45° FOV.
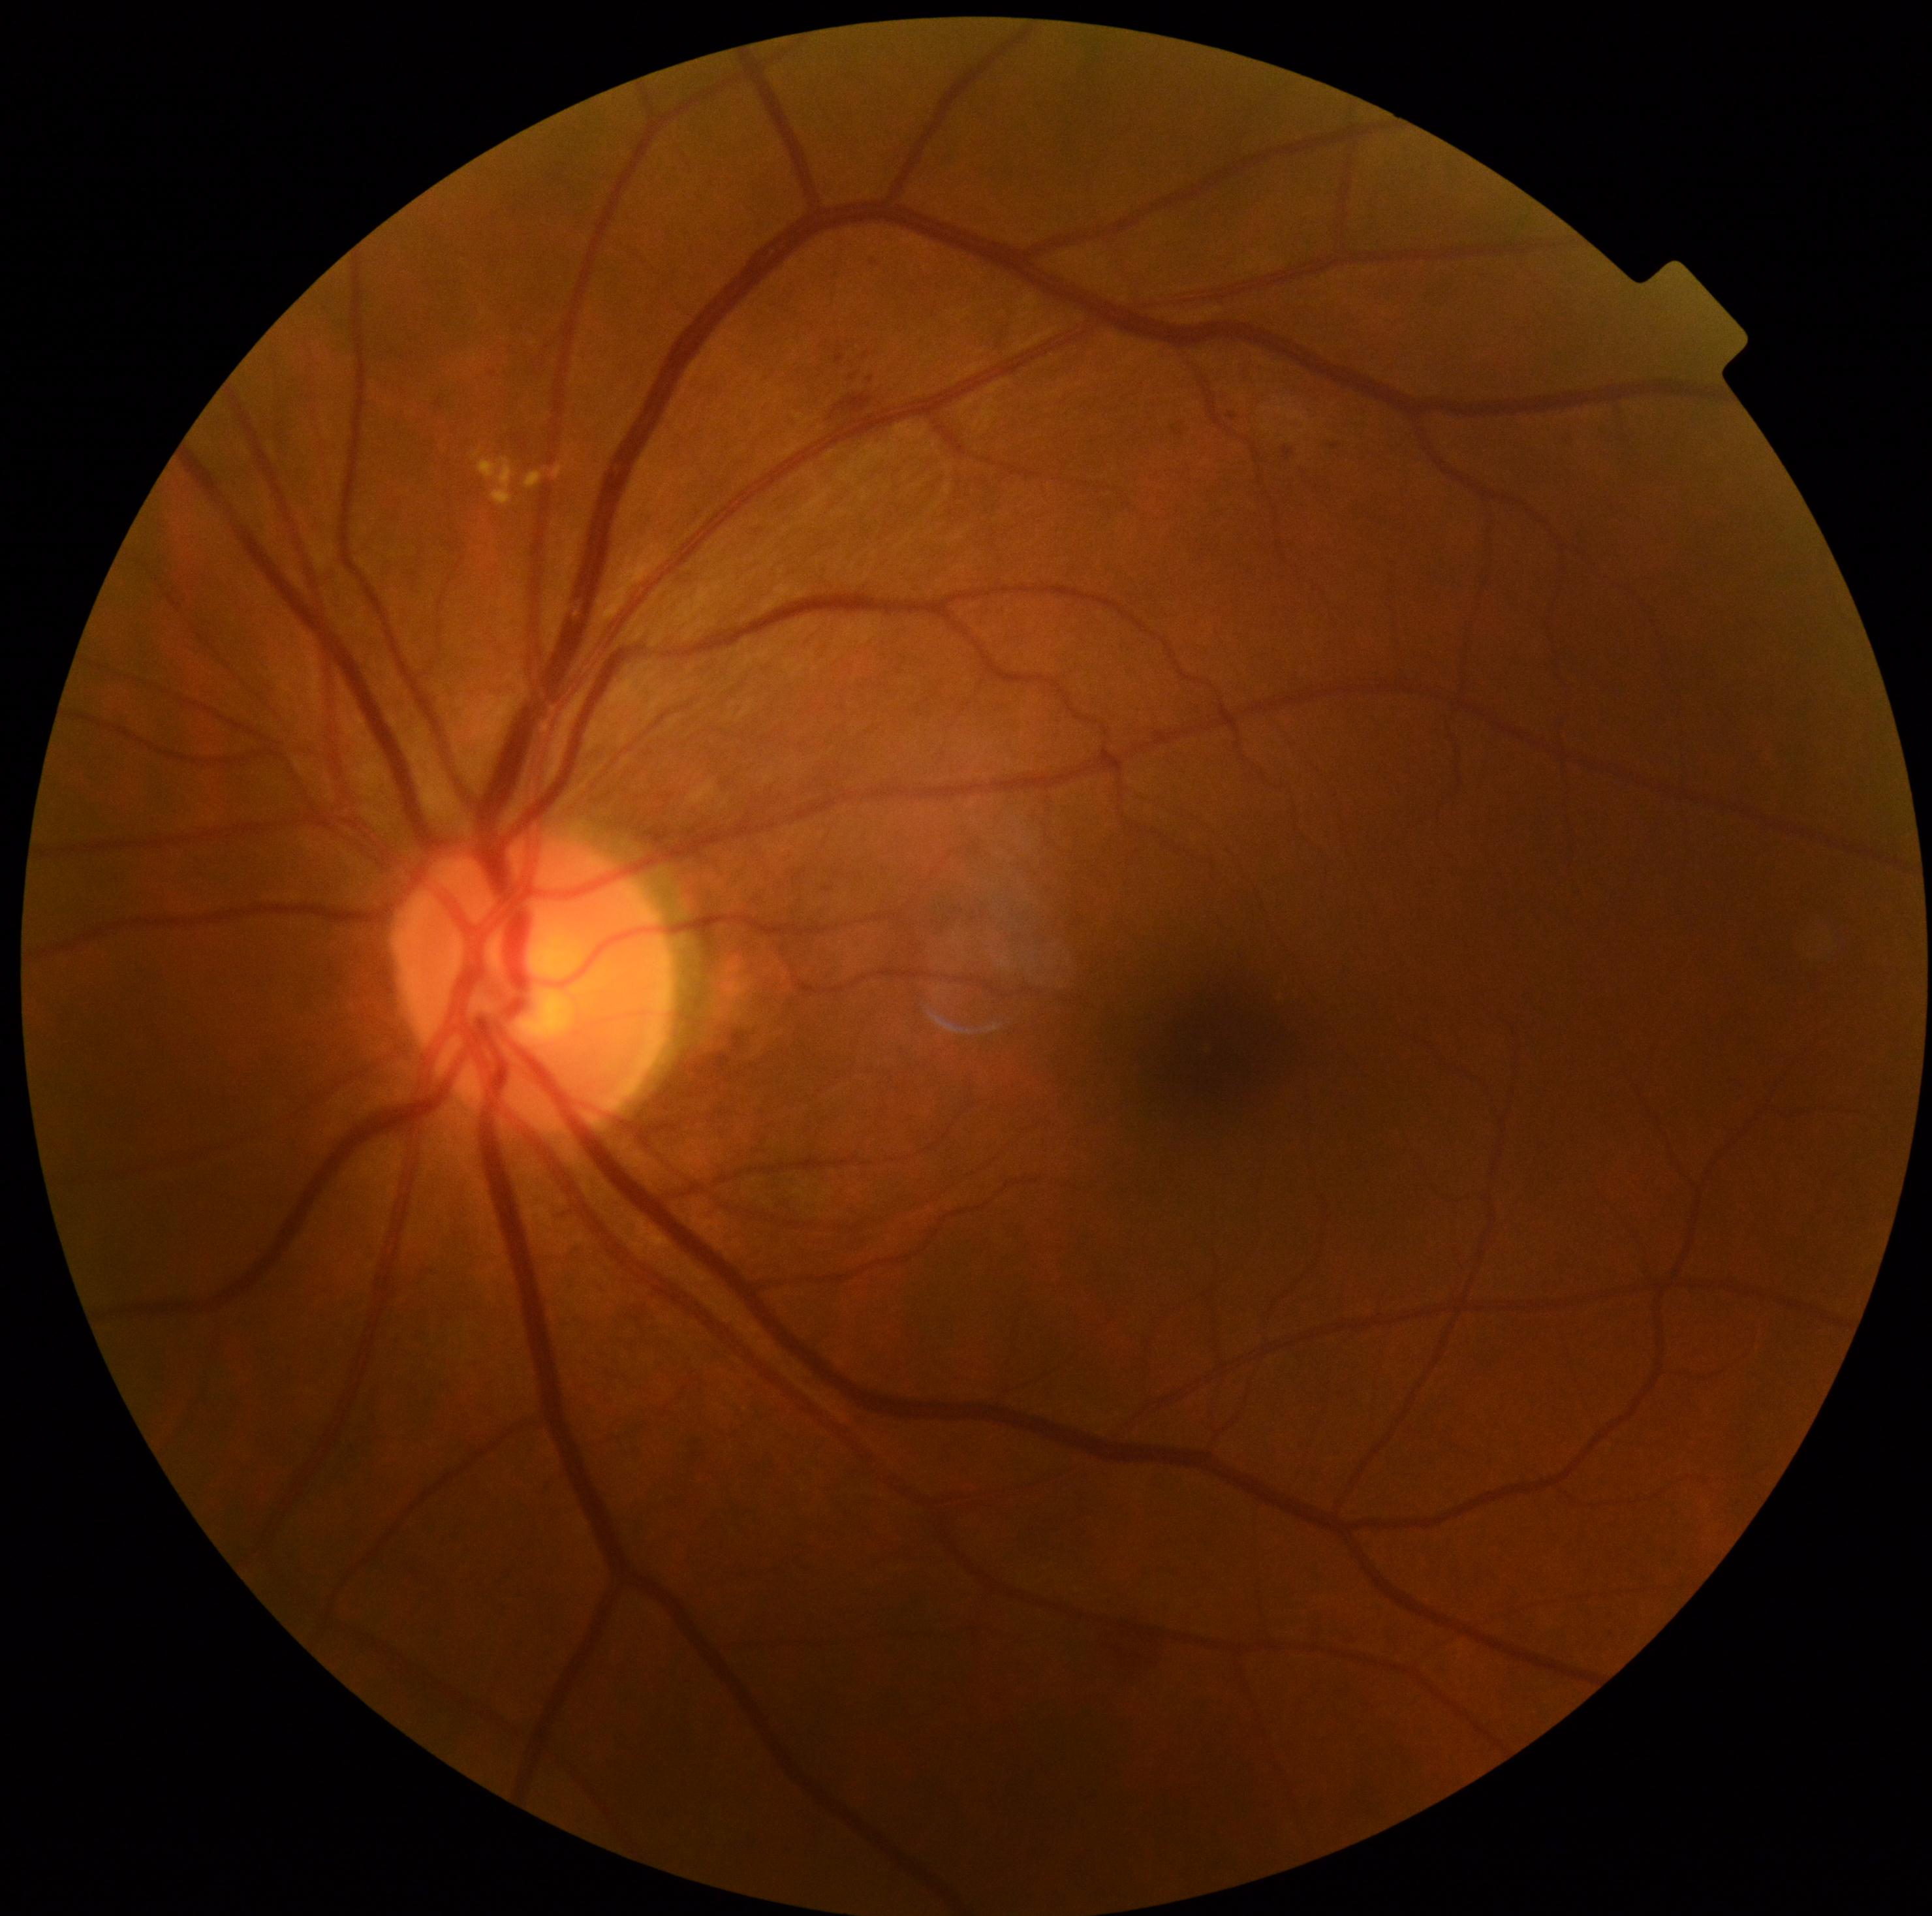

Retinopathy: grade 2 (moderate NPDR) — more than just microaneurysms but less than severe NPDR.